45° field of view
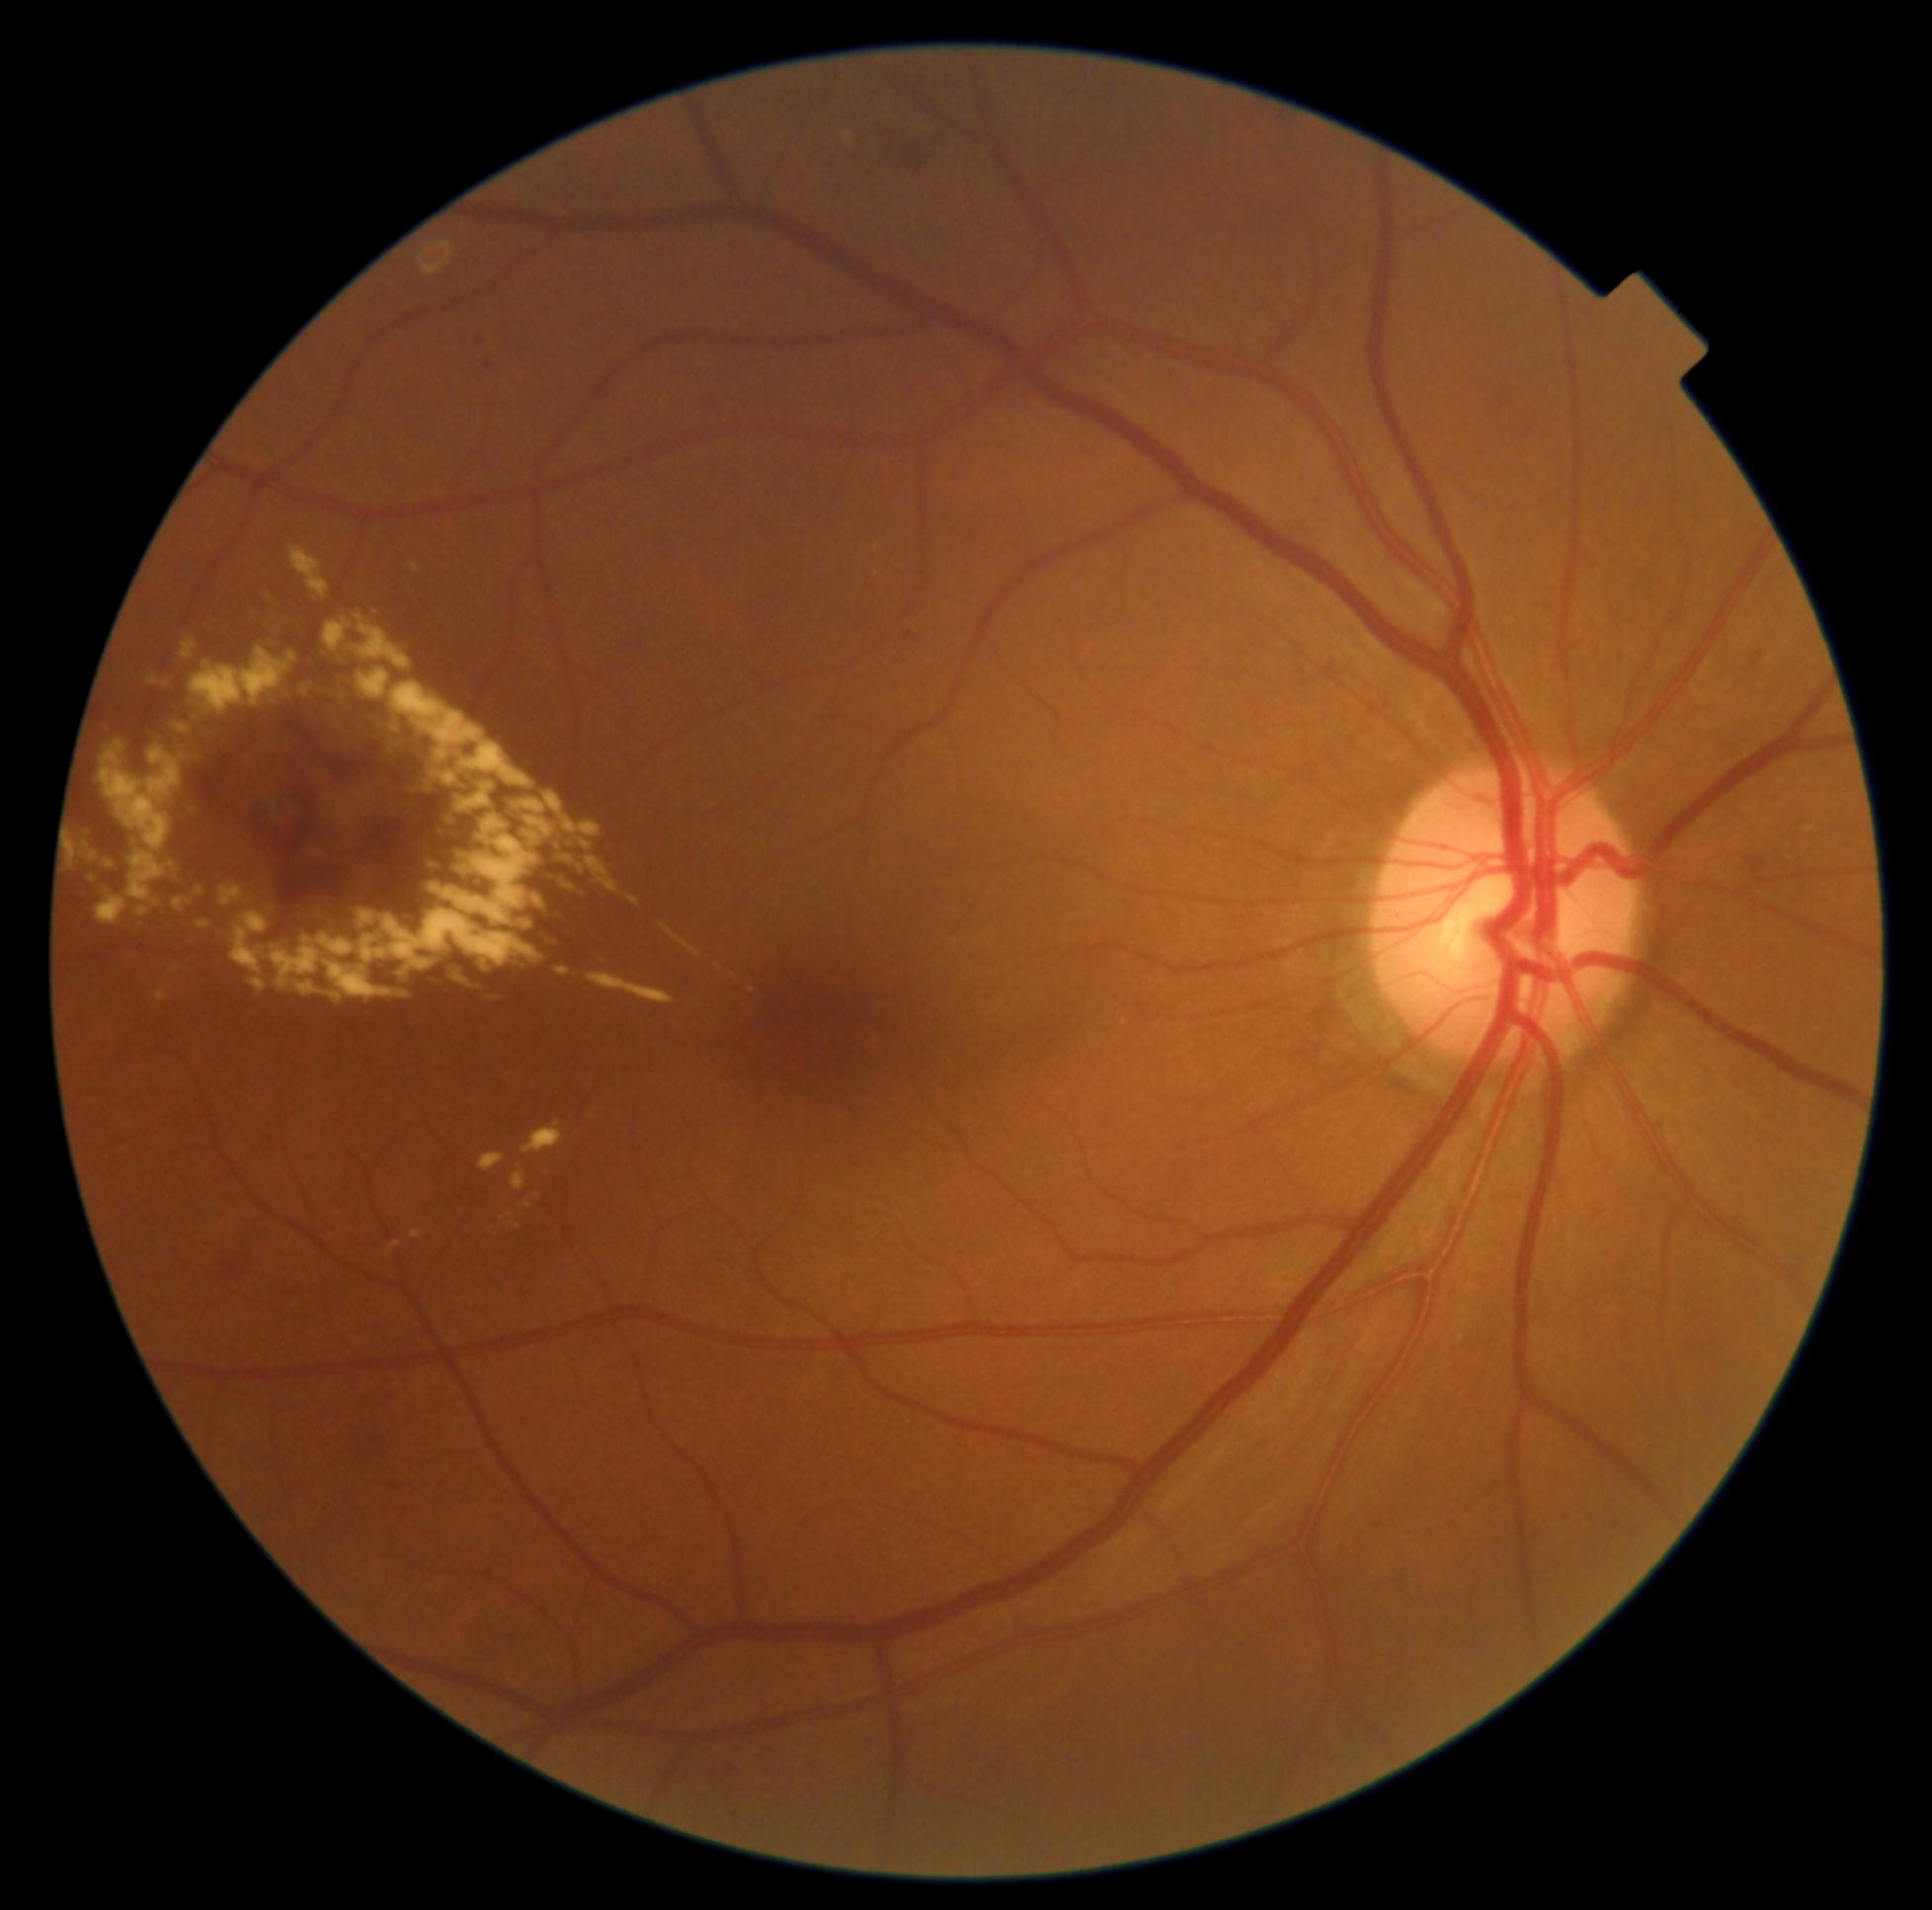

Diabetic retinopathy (DR): grade 2 (moderate NPDR) — more than just microaneurysms but less than severe NPDR
A subset of detected lesions:
hemorrhages (HEs): left=306, top=743, right=370, bottom=777; left=1746, top=857, right=1768, bottom=873; left=702, top=392, right=723, bottom=410; left=1497, top=392, right=1515, bottom=412; left=249, top=769, right=318, bottom=855; left=892, top=128, right=949, bottom=170; left=1750, top=652, right=1765, bottom=672; left=225, top=1249, right=263, bottom=1282; left=302, top=813, right=399, bottom=888
HEs (small, approximate centers) near point(390, 809)
soft exudates (SEs): none detected
hard exudates (EXs) (continued): left=289, top=547, right=329, bottom=597; left=307, top=659, right=322, bottom=673; left=524, top=1201, right=533, bottom=1208; left=355, top=793, right=370, bottom=800; left=267, top=910, right=544, bottom=998; left=419, top=780, right=443, bottom=798; left=324, top=793, right=356, bottom=831; left=353, top=613, right=412, bottom=670; left=555, top=967, right=571, bottom=978; left=65, top=839, right=76, bottom=861; left=337, top=681, right=344, bottom=701; left=333, top=657, right=344, bottom=666; left=844, top=132, right=854, bottom=146; left=520, top=919, right=553, bottom=943
EXs (small, approximate centers) near point(110, 865); point(511, 1216); point(719, 967)
microaneurysms (MAs): left=286, top=1285, right=302, bottom=1298; left=403, top=1507, right=408, bottom=1516; left=905, top=632, right=917, bottom=643; left=362, top=1389, right=370, bottom=1398; left=1082, top=445, right=1087, bottom=454; left=390, top=1480, right=403, bottom=1491
MAs (small, approximate centers) near point(375, 1440); point(755, 673); point(443, 1484); point(392, 1396); point(1387, 706)